Fundus photo: 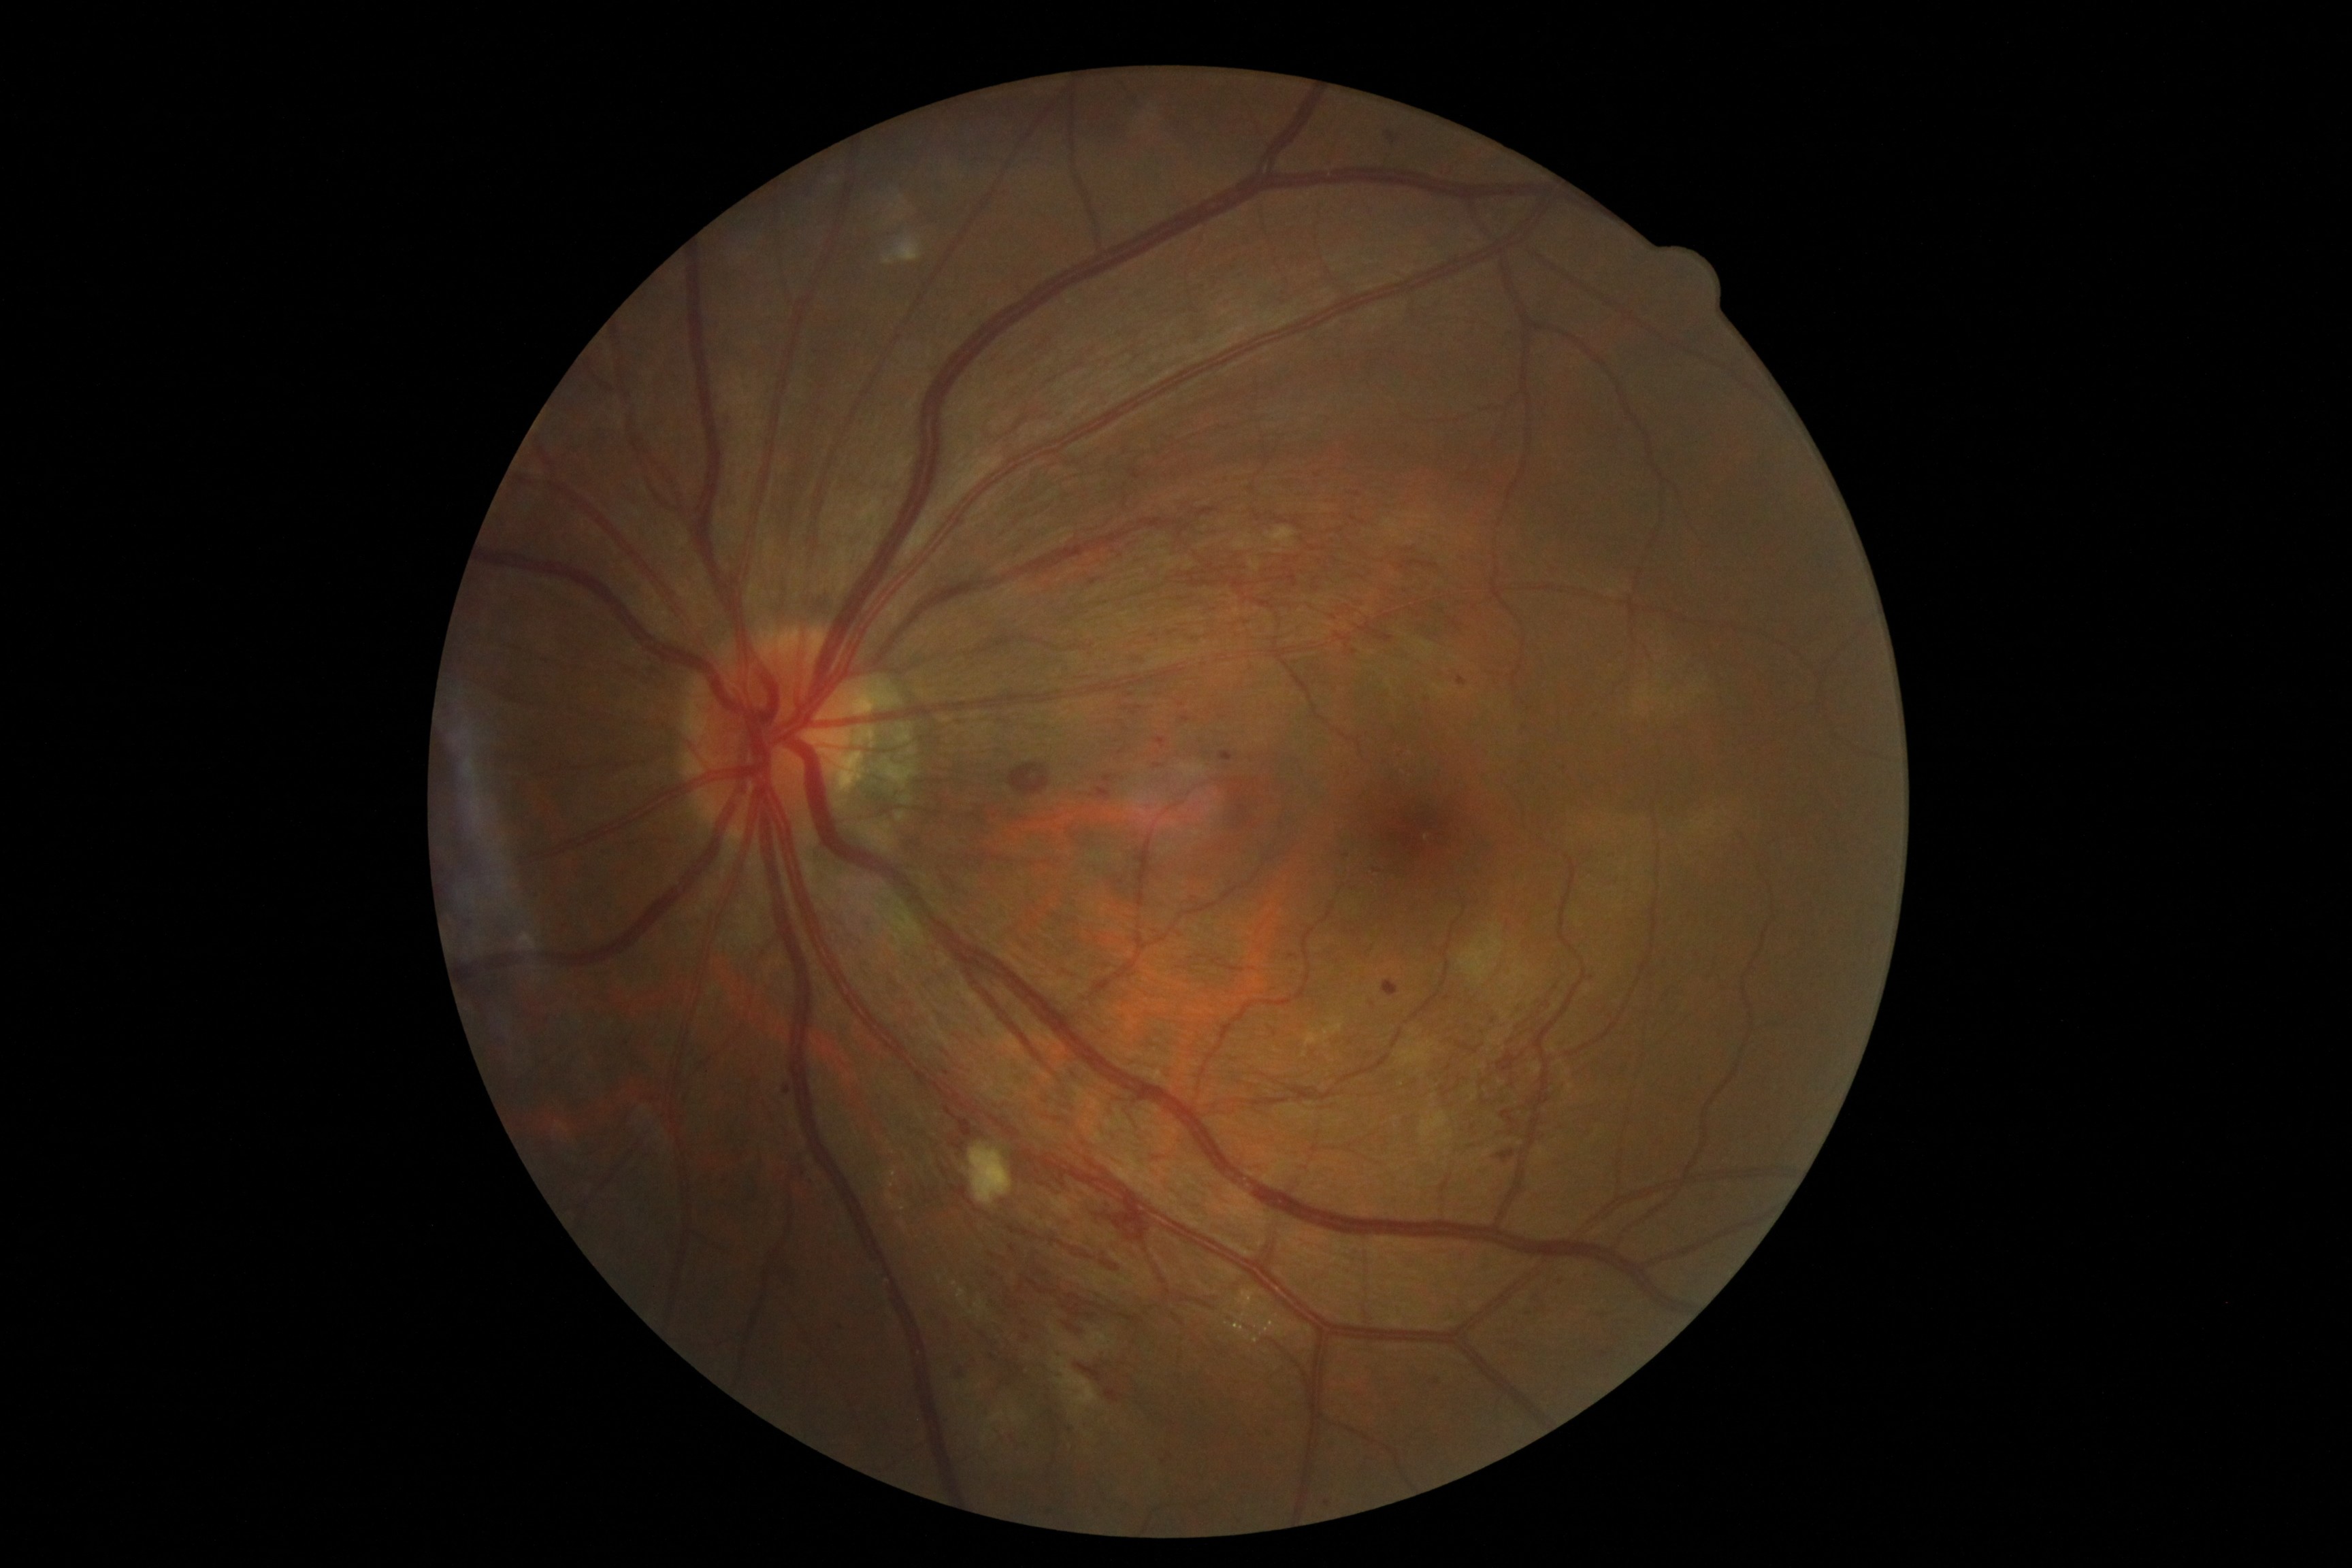 The retinopathy is classified as non-proliferative diabetic retinopathy.
Diabetic retinopathy grade is severe NPDR (3).